Pediatric wide-field fundus photograph; camera: Phoenix ICON (100° FOV): 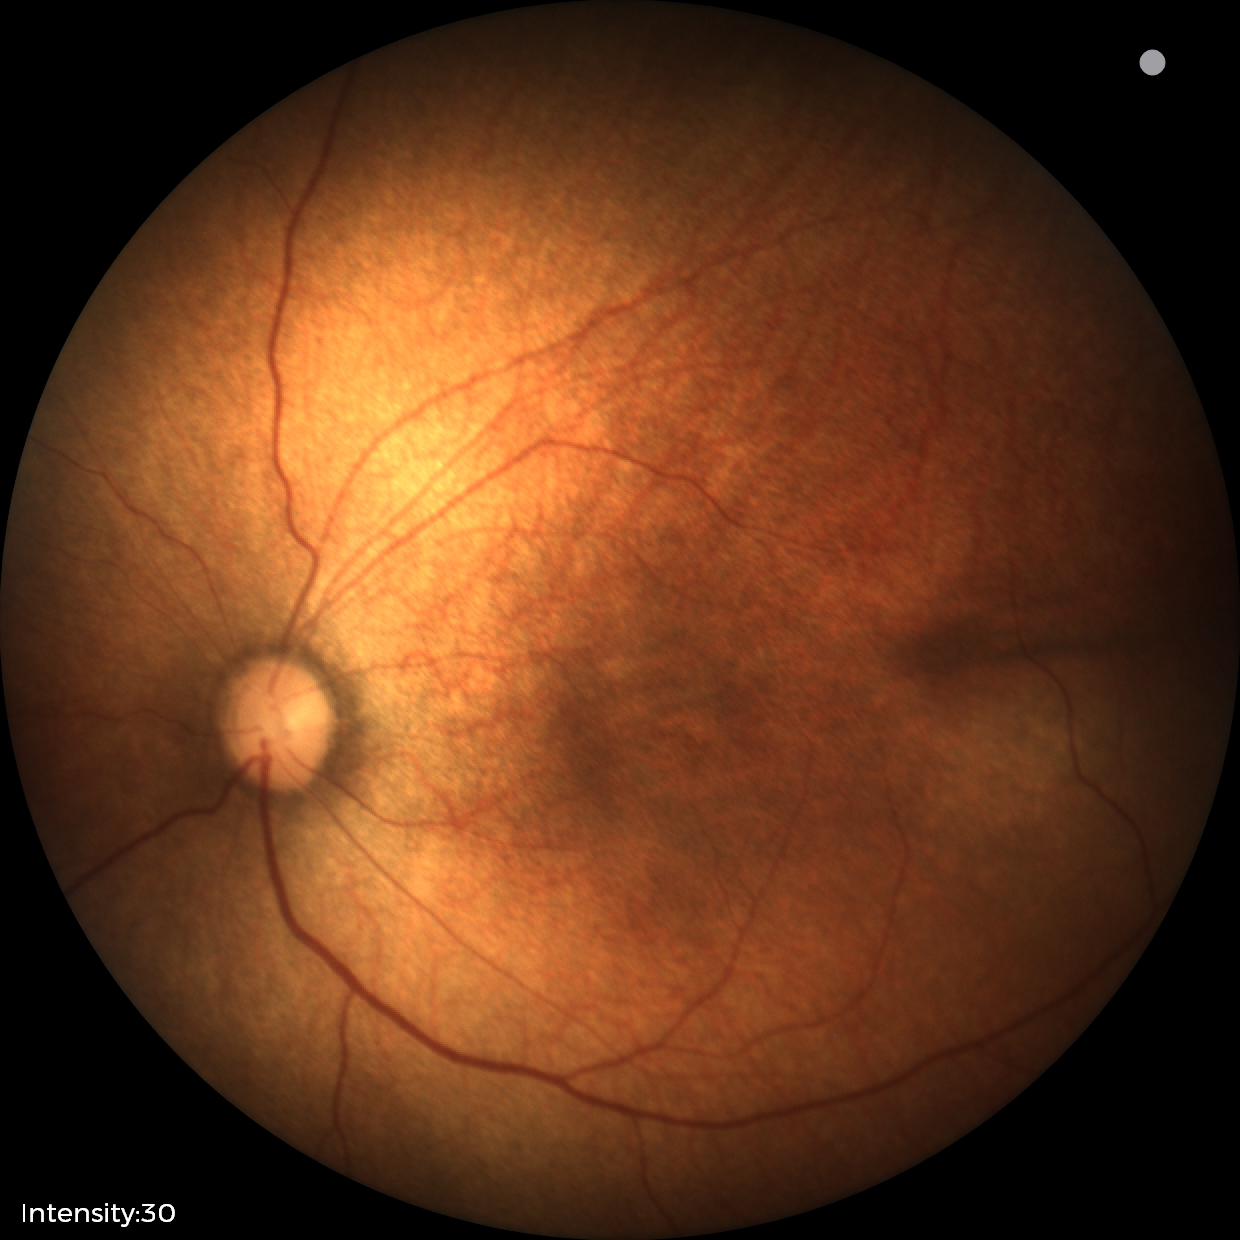 Screening diagnosis = normal retinal appearance.